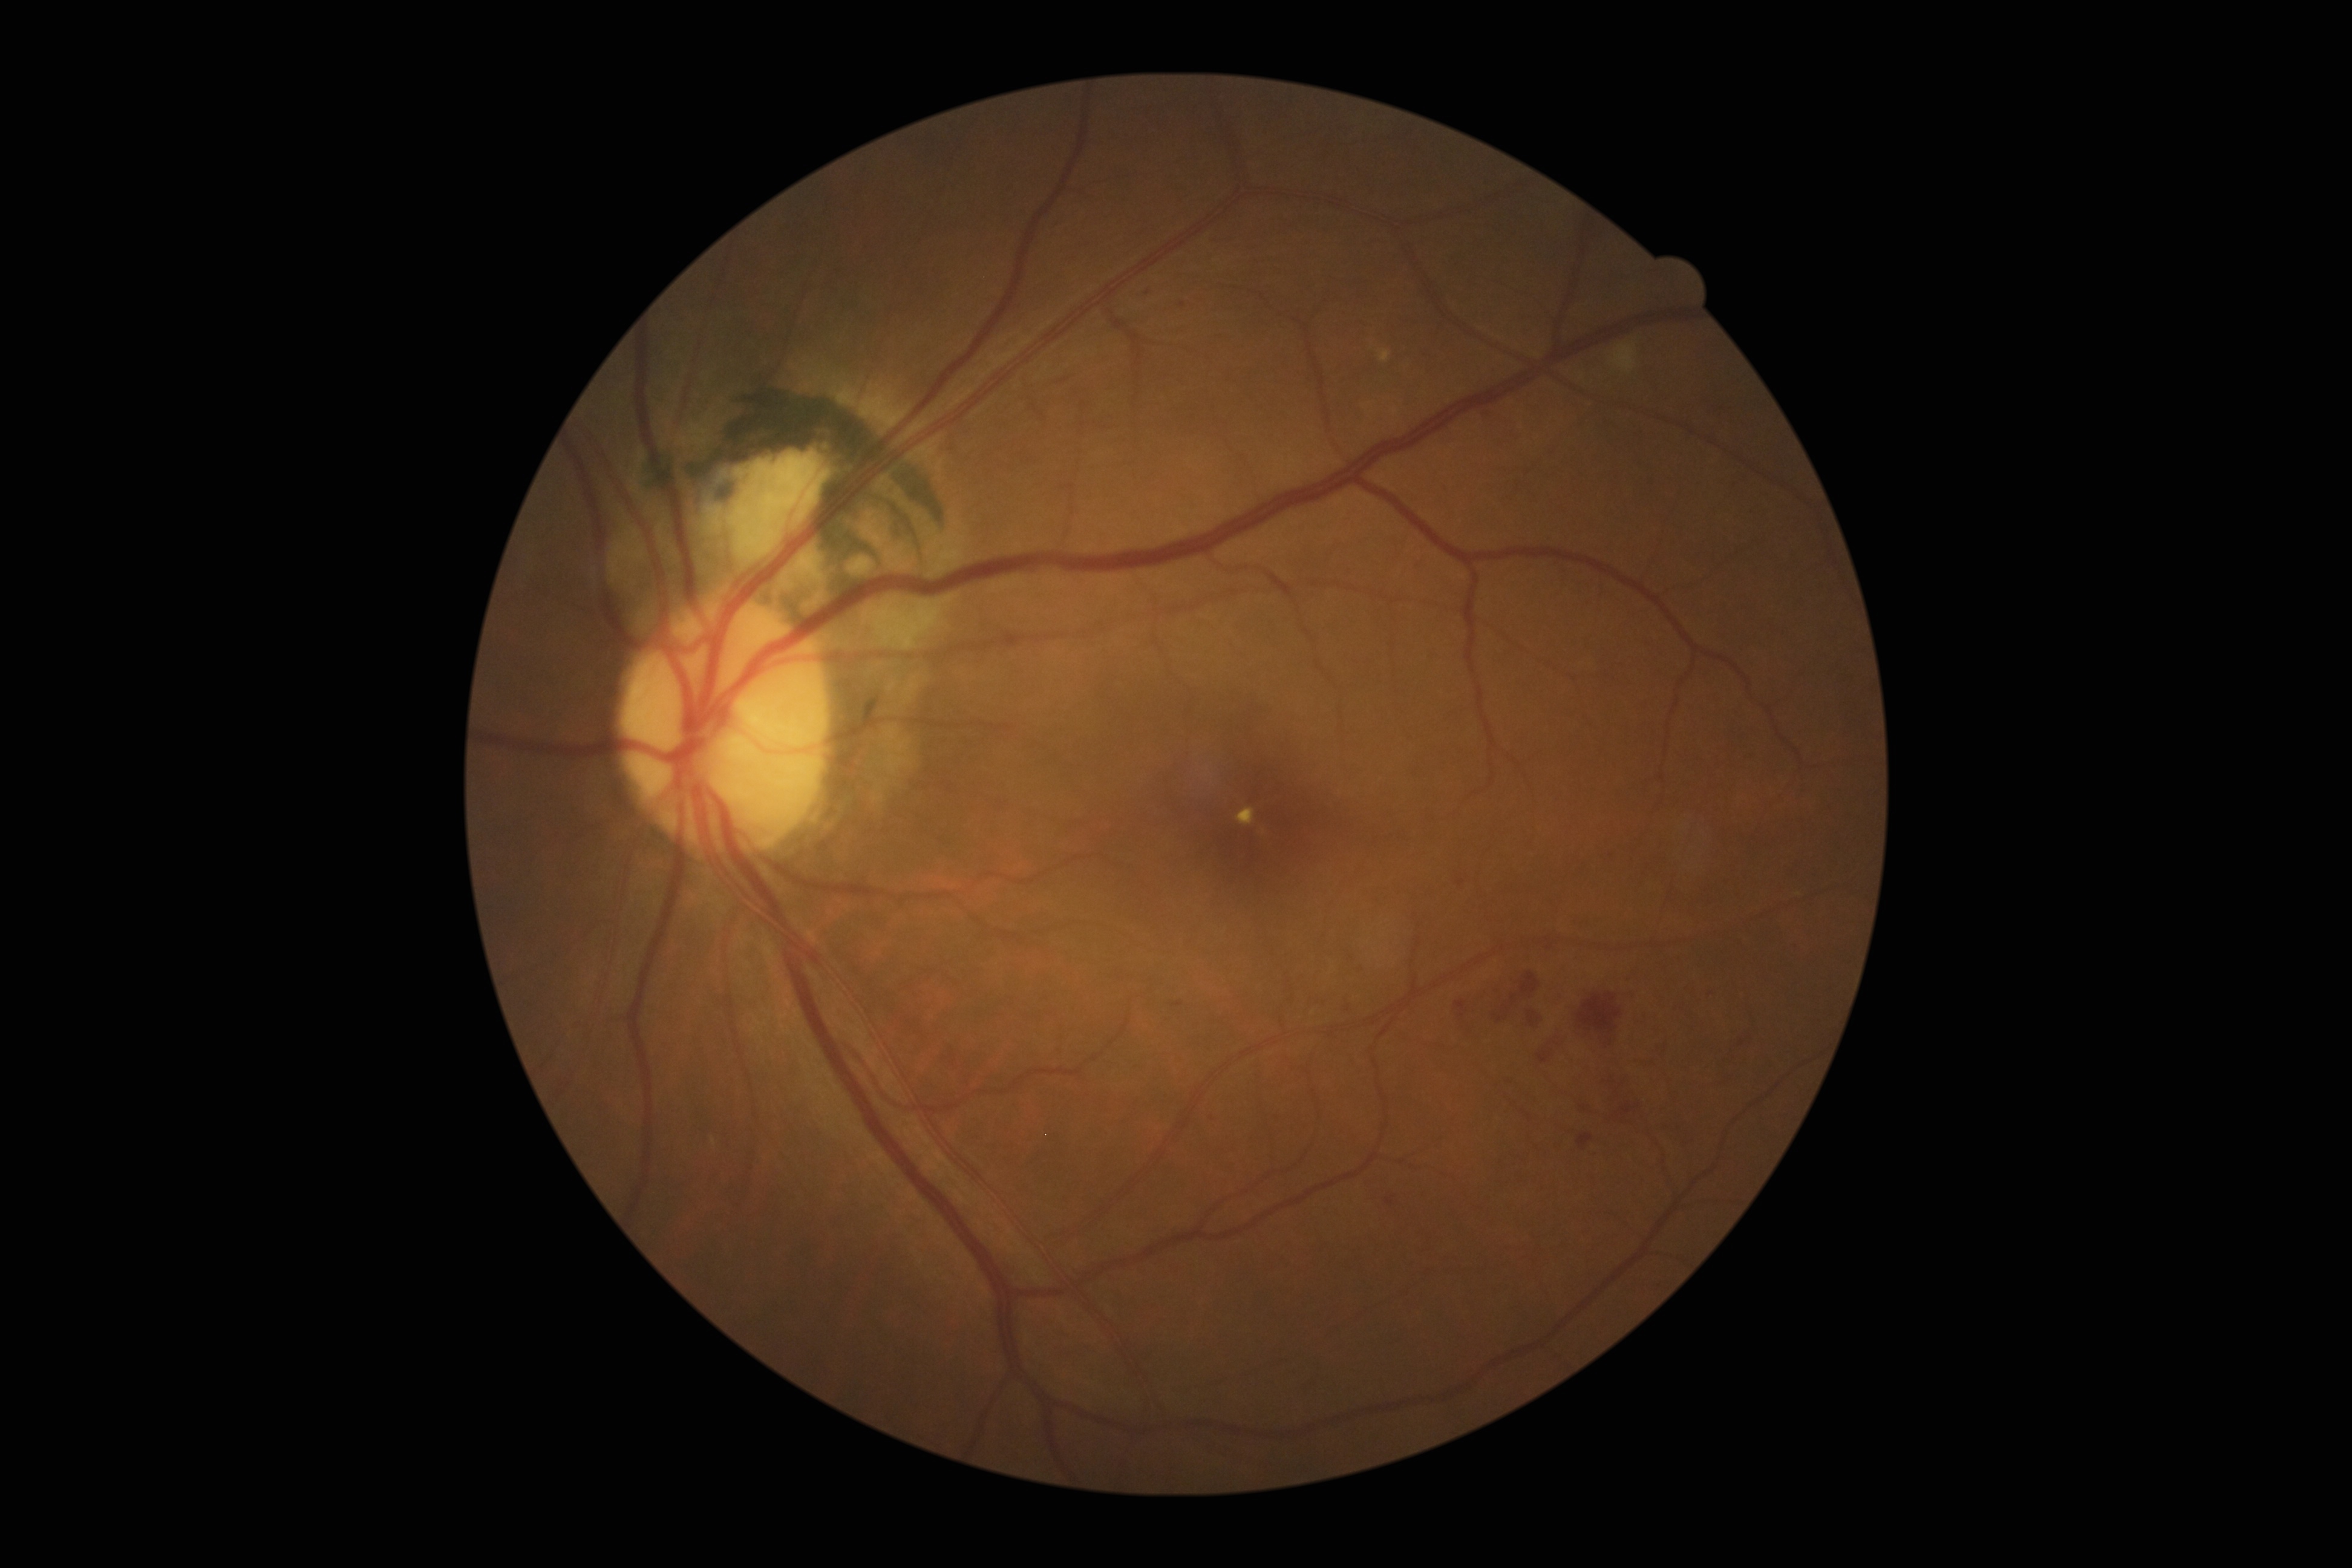

Diabetic retinopathy (DR) is grade 2 (moderate NPDR). Soft exudates (SEs) found at [x1=1611, y1=344, x2=1638, y2=373]. Hard exudates (EXs) include those at [x1=1393, y1=408, x2=1398, y2=416], [x1=1236, y1=808, x2=1255, y2=826], [x1=1379, y1=350, x2=1392, y2=362]. Microaneurysms (MAs) include those at [x1=1745, y1=754, x2=1757, y2=762], [x1=1546, y1=946, x2=1554, y2=950], [x1=1502, y1=1005, x2=1511, y2=1012], [x1=1169, y1=1001, x2=1185, y2=1007], [x1=1385, y1=1196, x2=1397, y2=1207], [x1=1577, y1=1133, x2=1594, y2=1151]. Small MAs near {"x": 1637, "y": 1061}, {"x": 1275, "y": 1119}, {"x": 1349, "y": 575}, {"x": 1487, "y": 414}, {"x": 1518, "y": 490}, {"x": 1212, "y": 1118}, {"x": 1348, "y": 1008}, {"x": 1711, "y": 994}. Hemorrhages (HEs) include those at [x1=1537, y1=1040, x2=1559, y2=1064], [x1=1520, y1=971, x2=1541, y2=998], [x1=1527, y1=1011, x2=1542, y2=1028], [x1=1570, y1=987, x2=1624, y2=1045], [x1=1617, y1=1100, x2=1640, y2=1116]. Small HEs near {"x": 1618, "y": 1094}, {"x": 1613, "y": 1080}.